45-degree field of view: 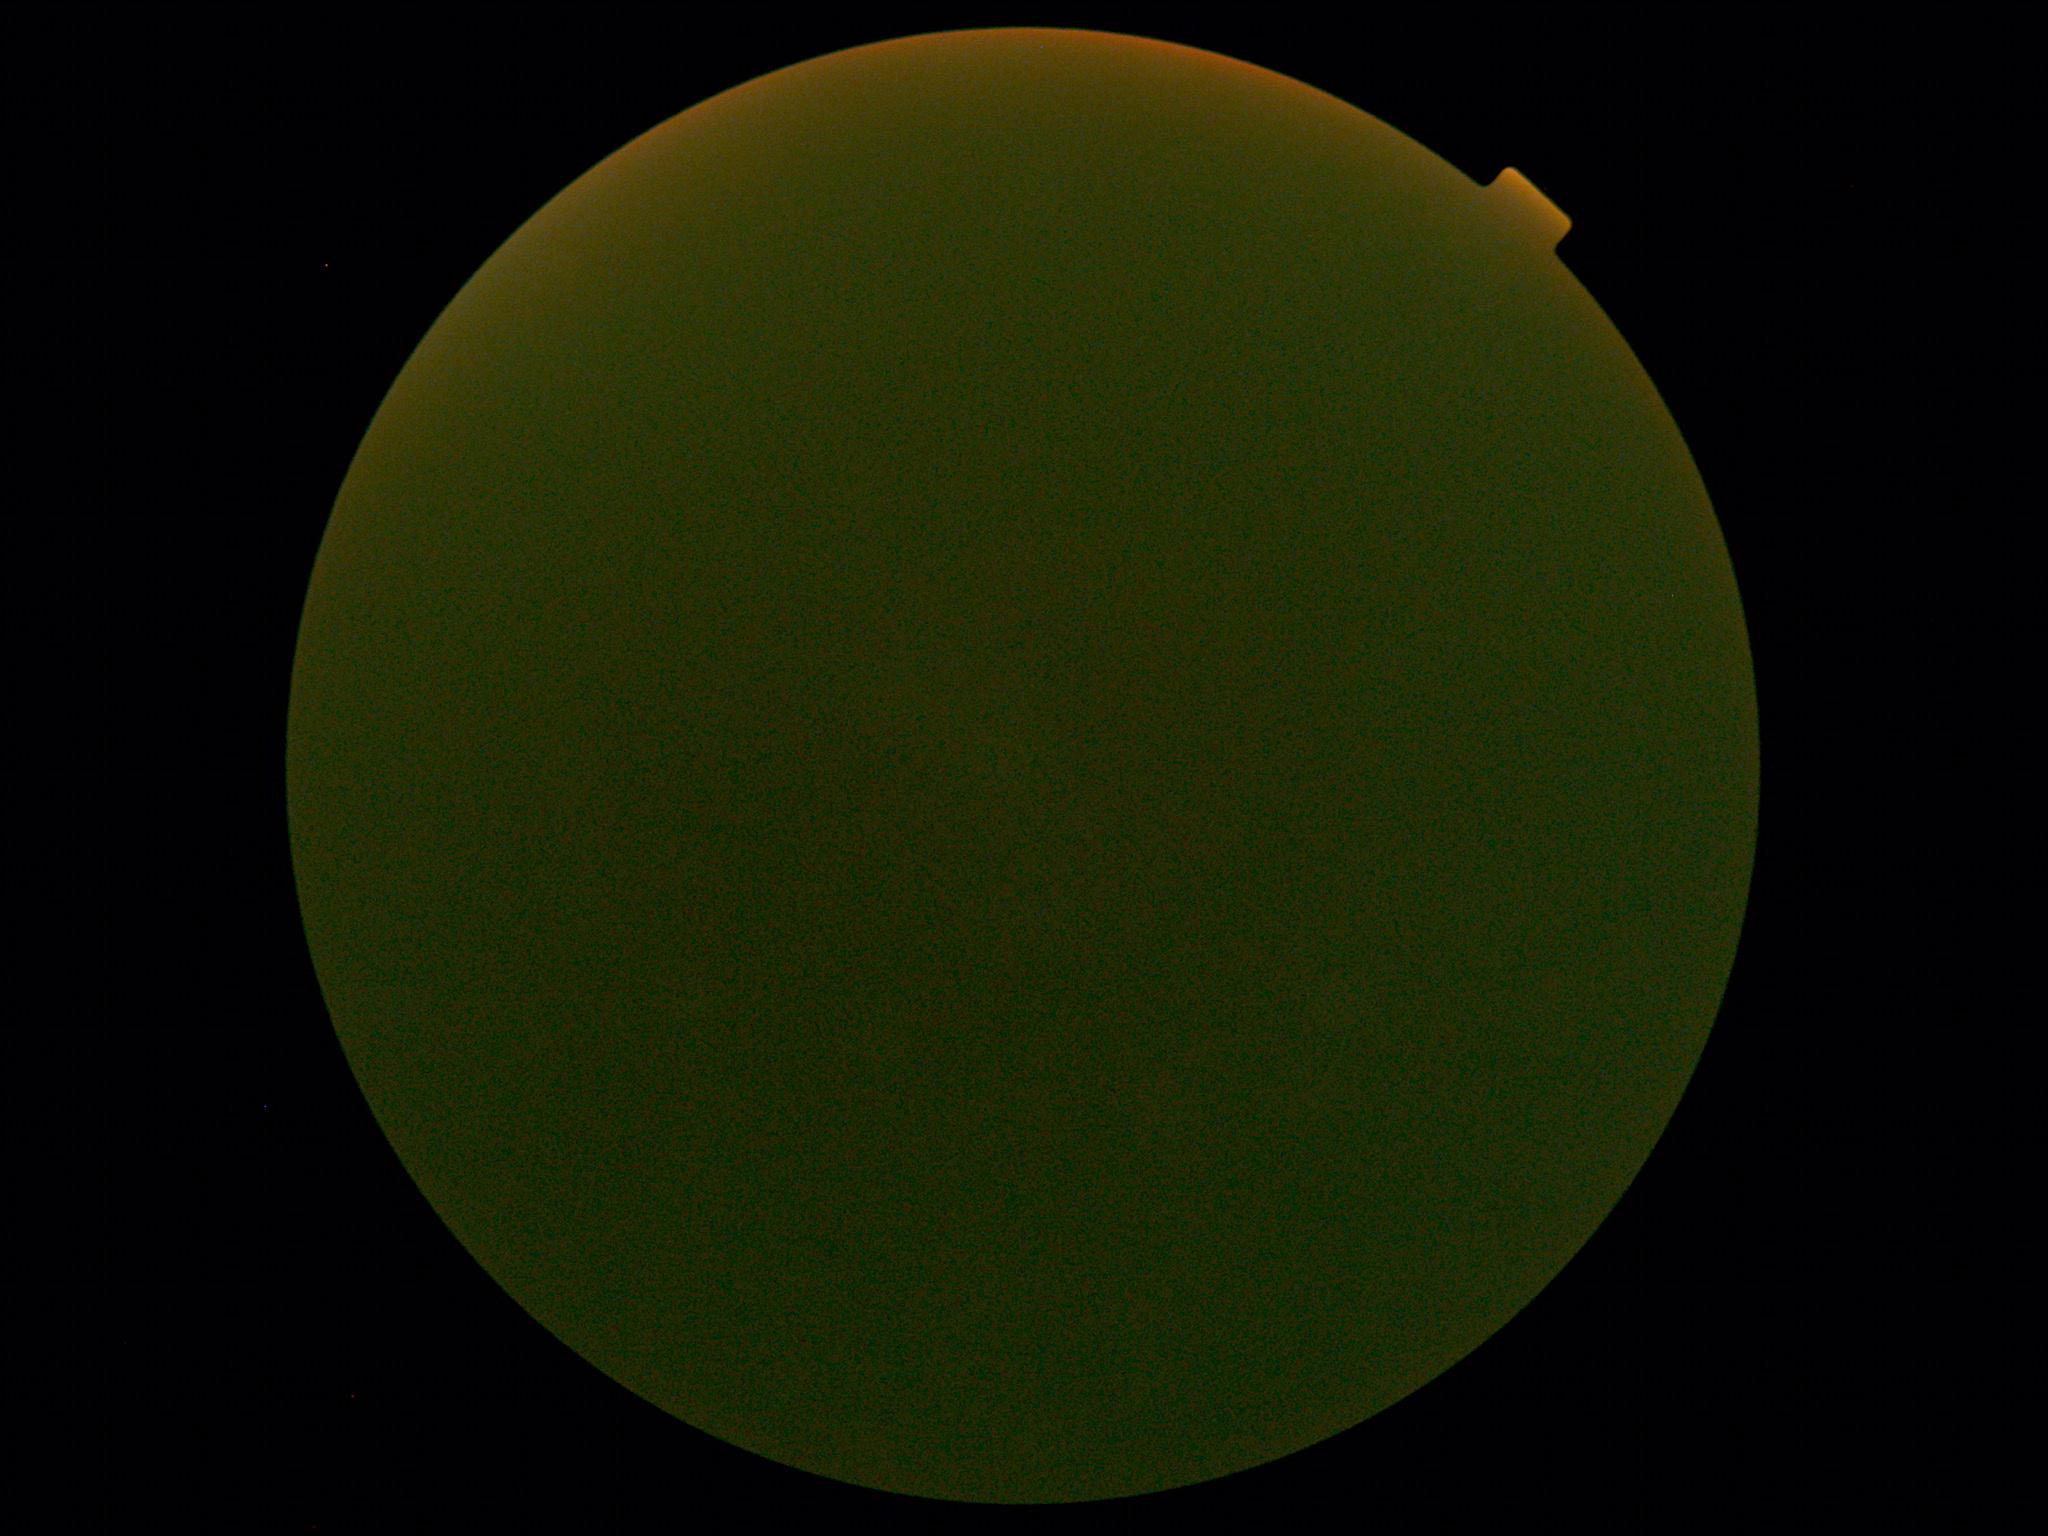
Diabetic retinopathy (DR) is ungradable due to poor image quality.